Wide-field fundus photograph of an infant · acquired on the Clarity RetCam 3: 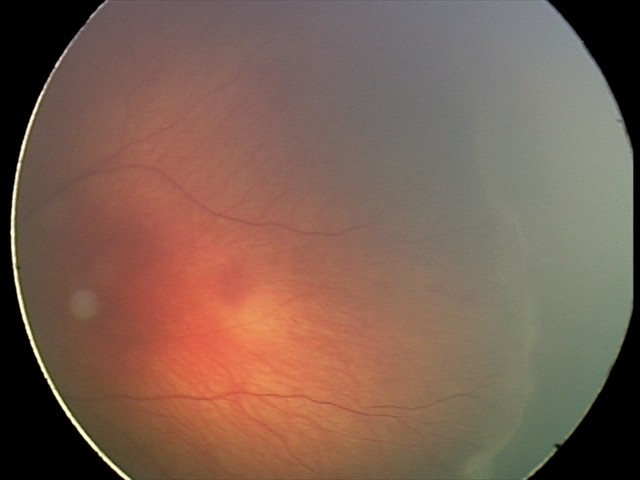

Assessment = retinopathy of prematurity stage 2; plus form = absent.